45° field of view — 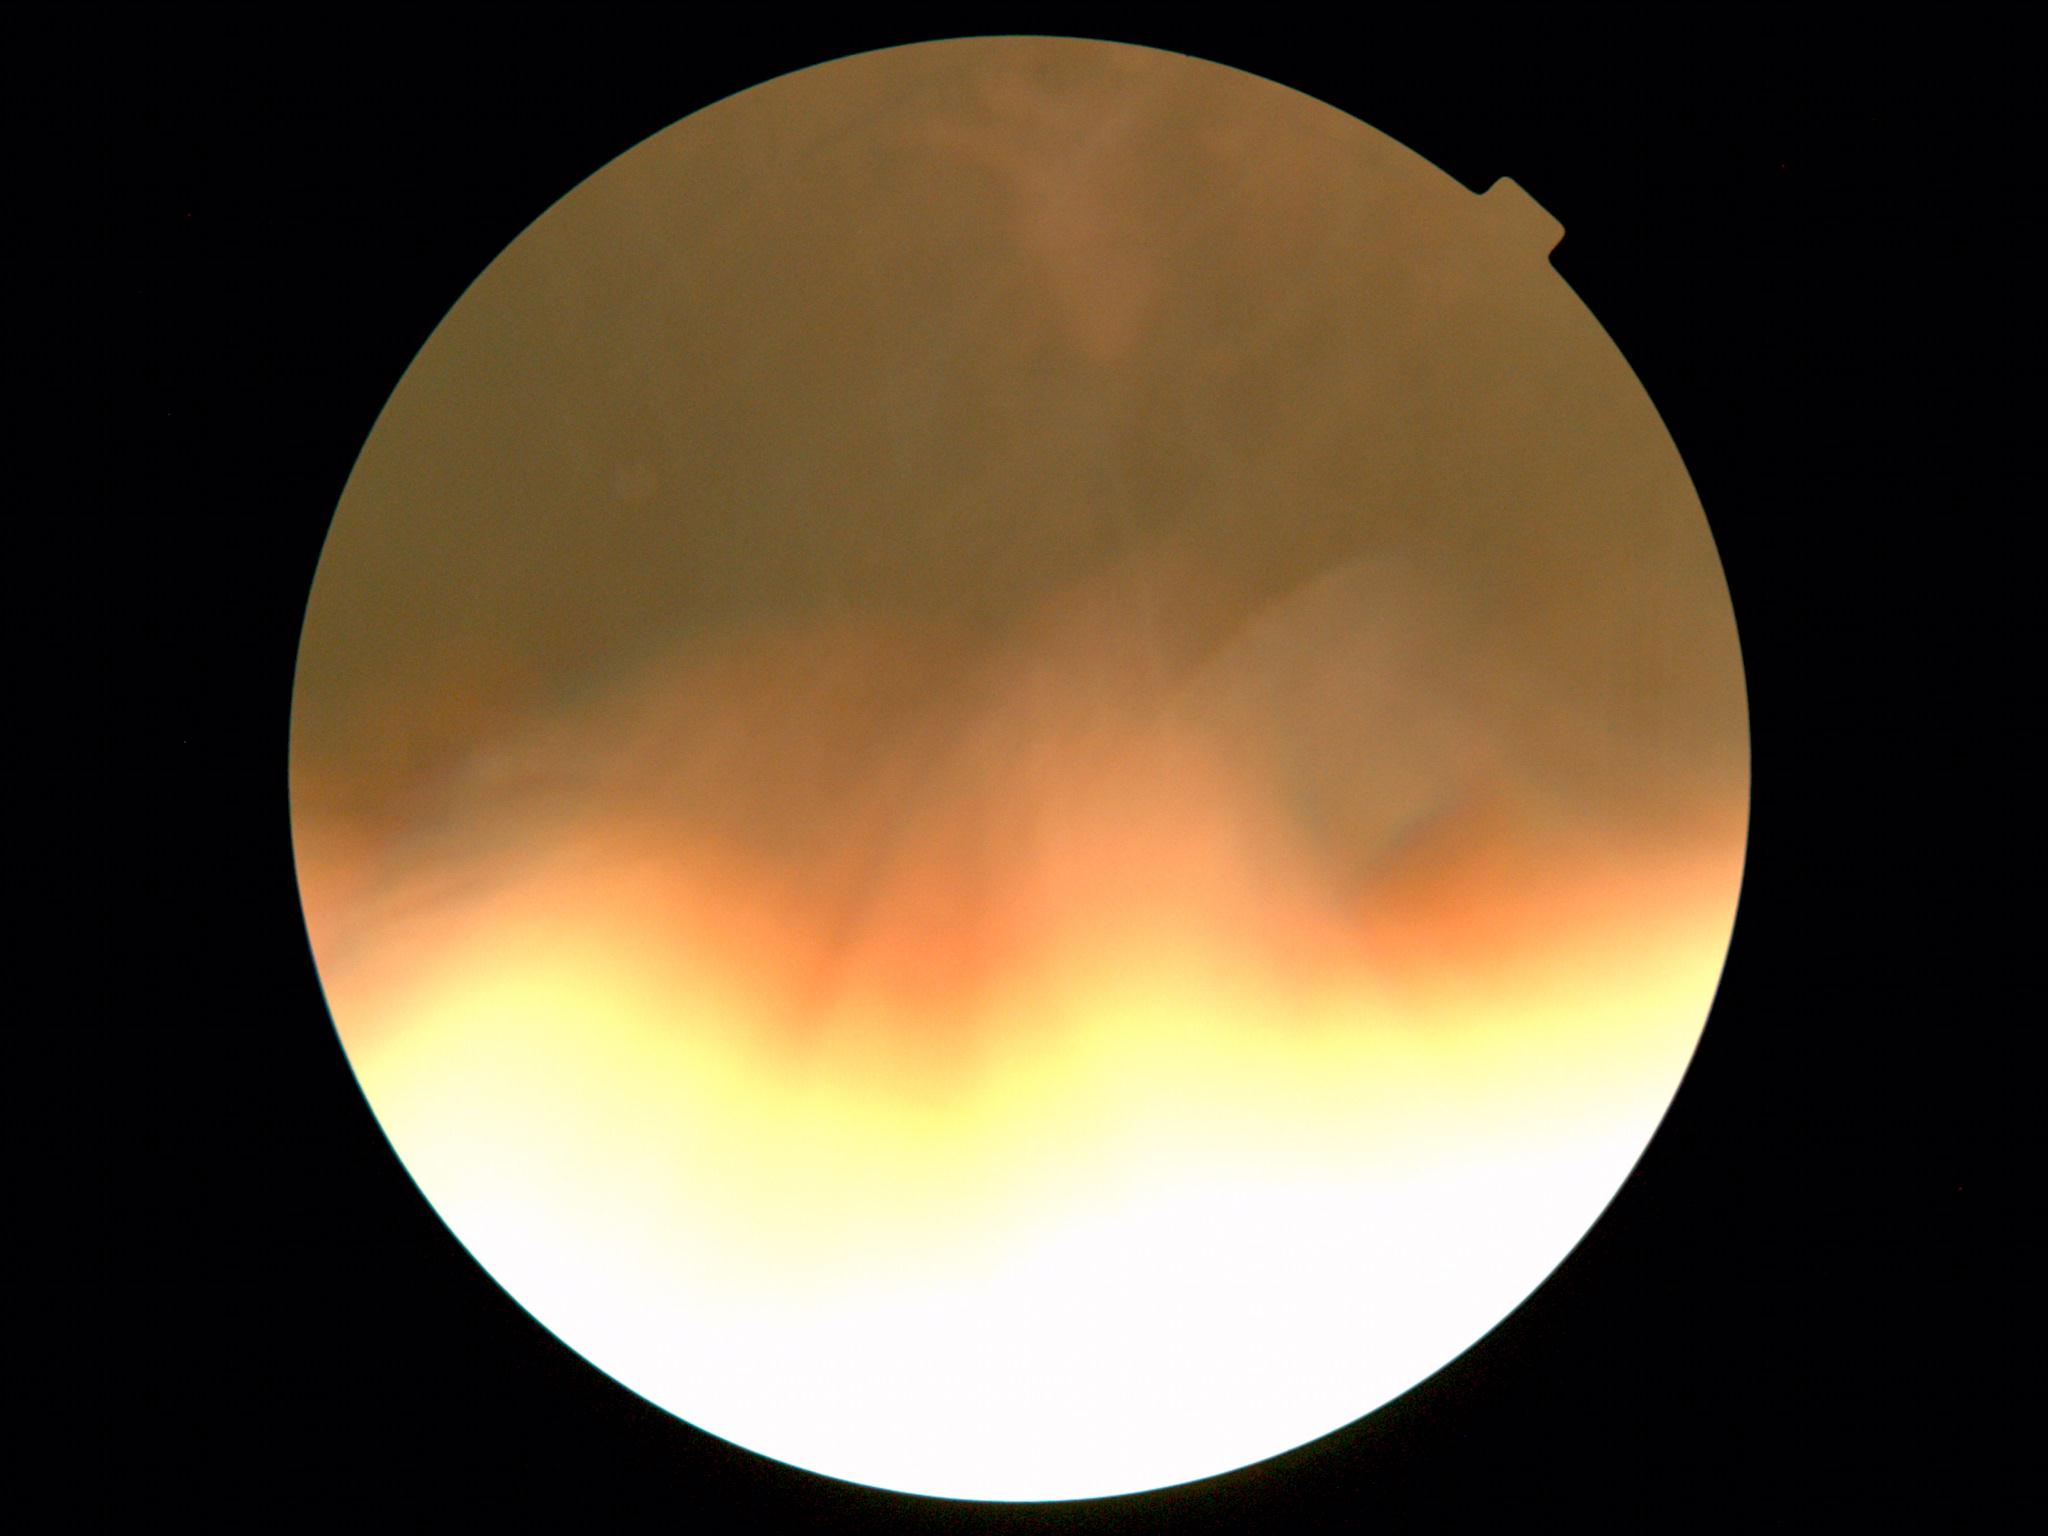

Image quality is insufficient for diabetic retinopathy assessment. DR stage is ungradable due to poor image quality.